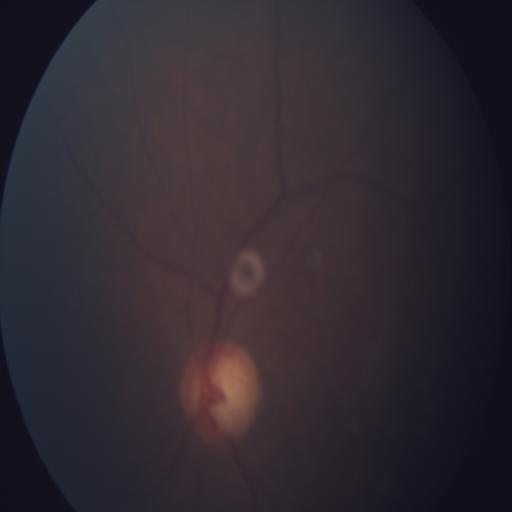
Abnormalities:
- optic disc cupping